640x480. Infant wide-field retinal image.
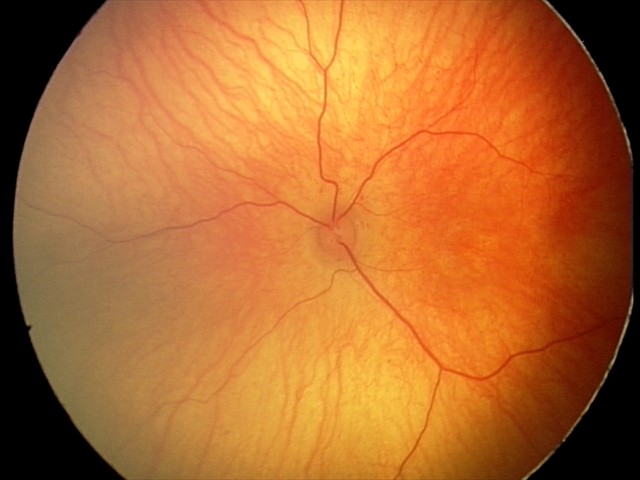
No retinal pathology identified on screening.